45° FOV, CFP, 2352x1568: 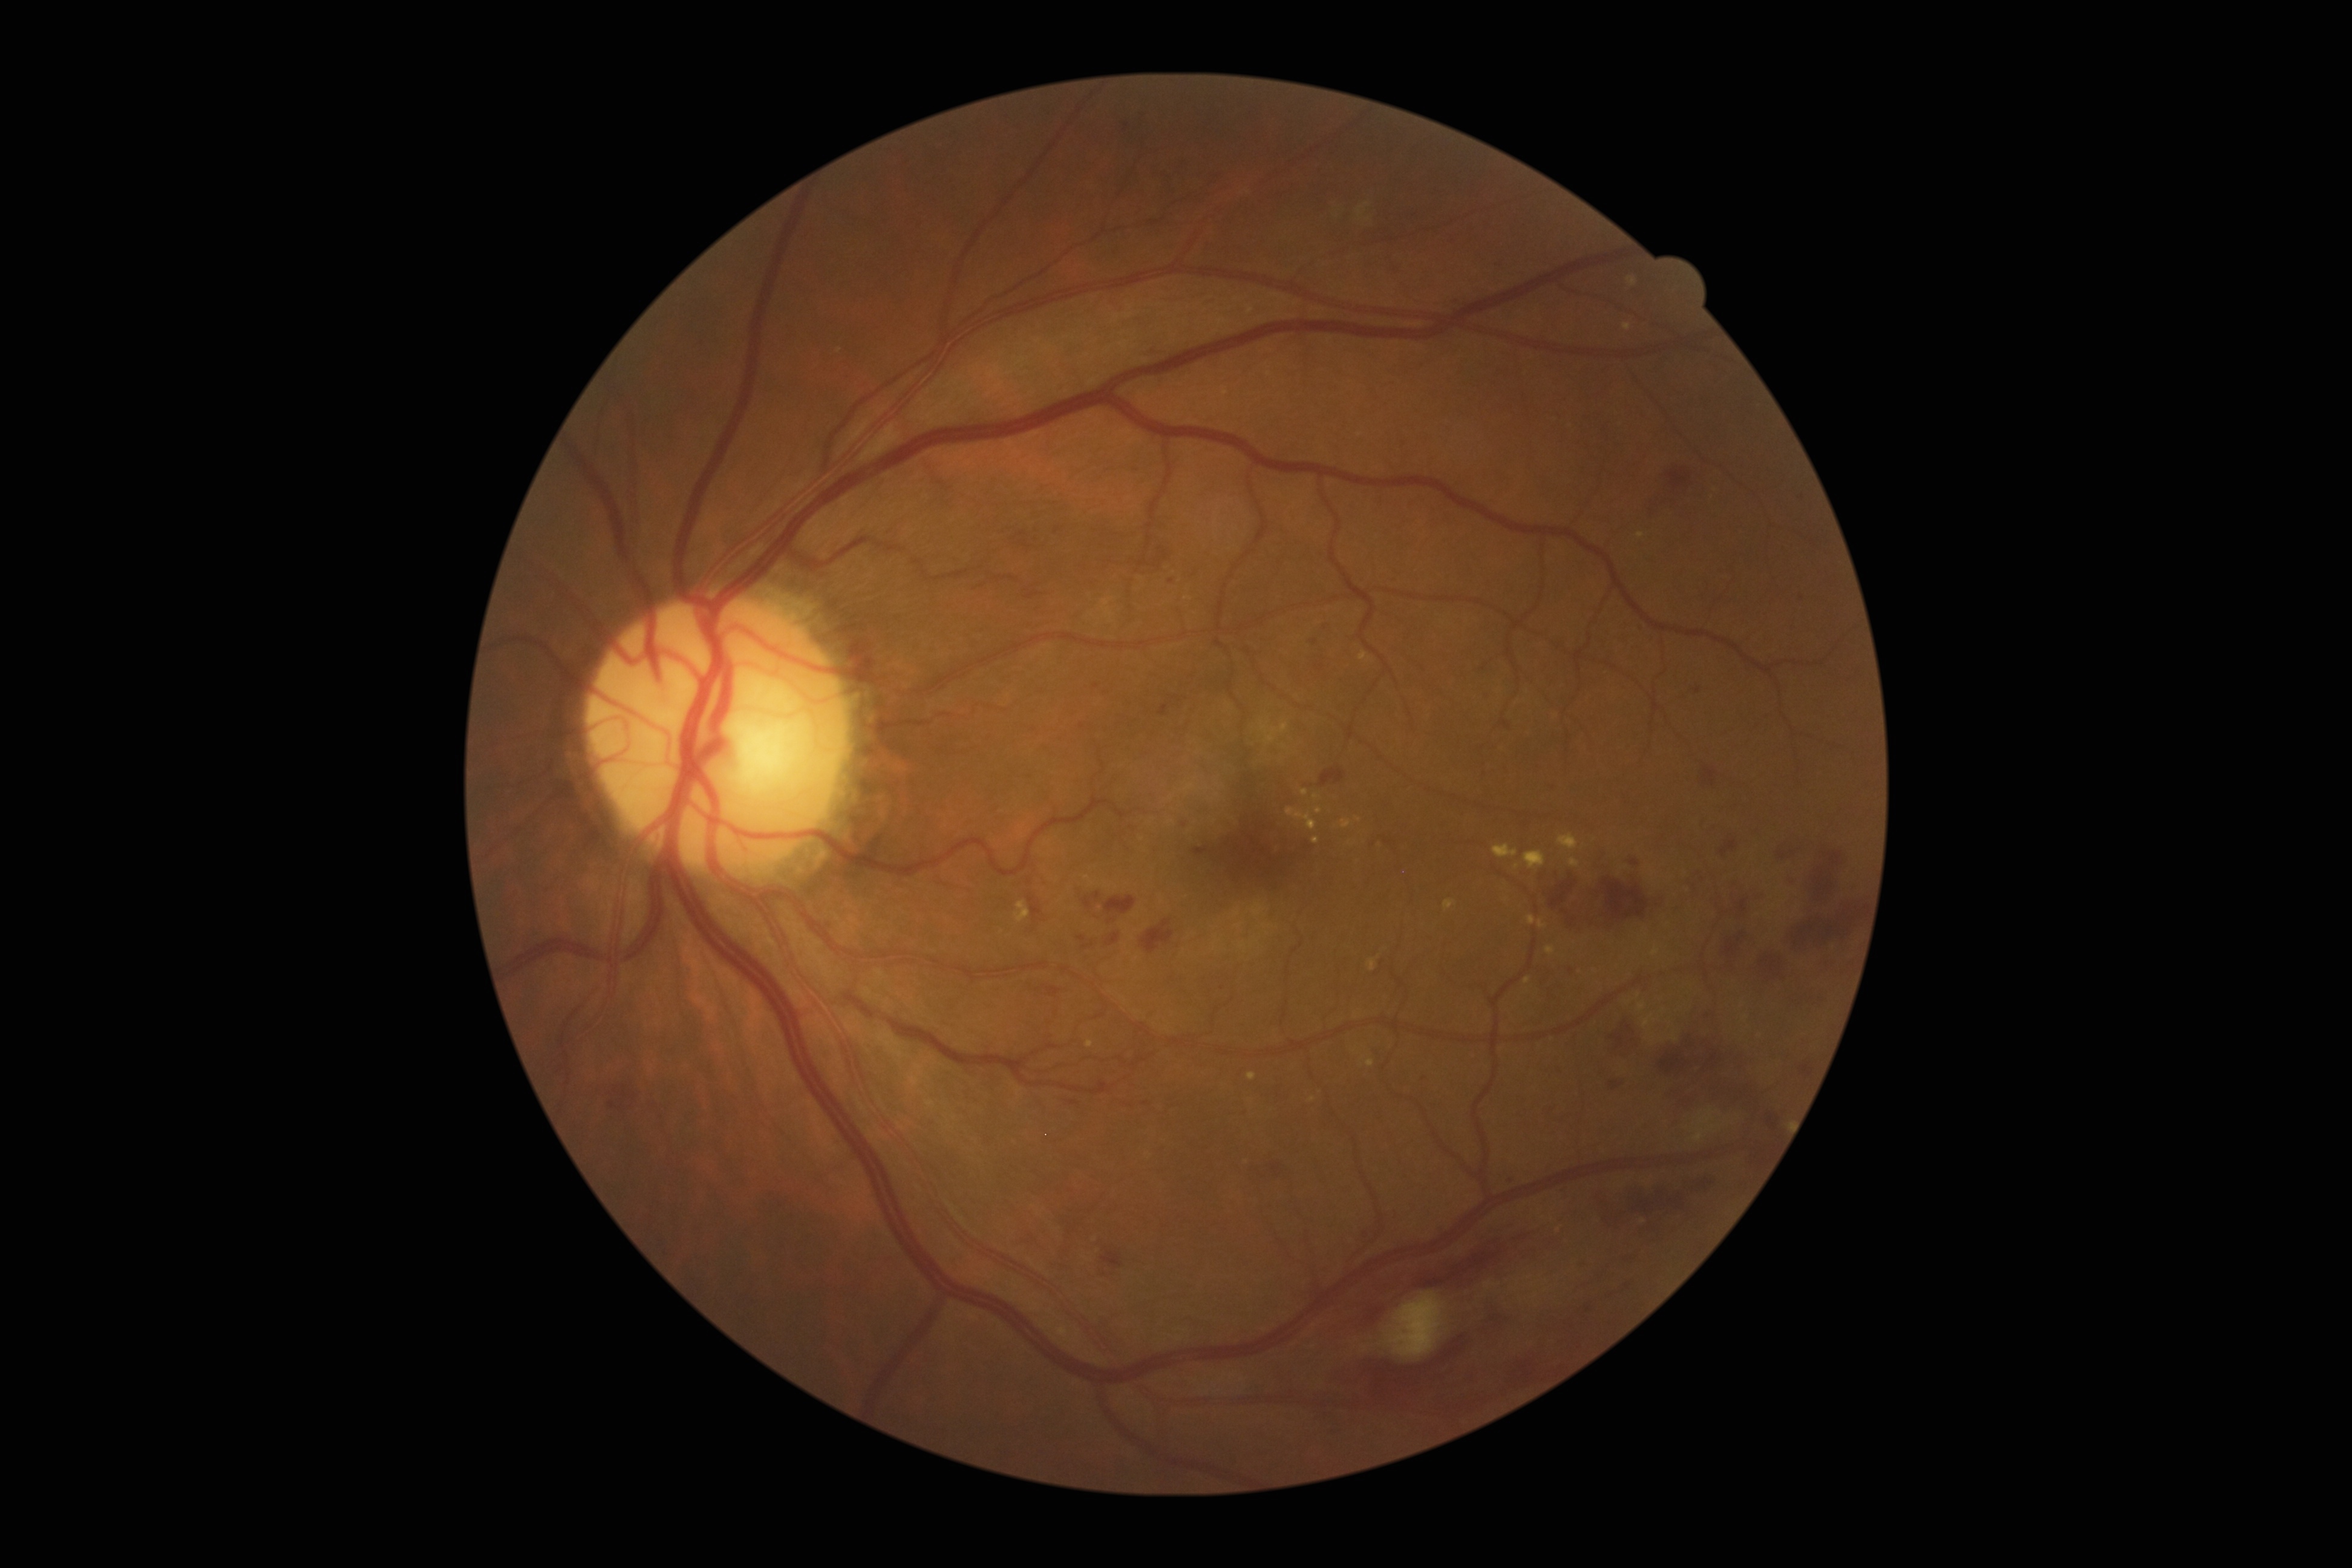

DR grade: 2. DR class: non-proliferative diabetic retinopathy.